Color fundus photograph.
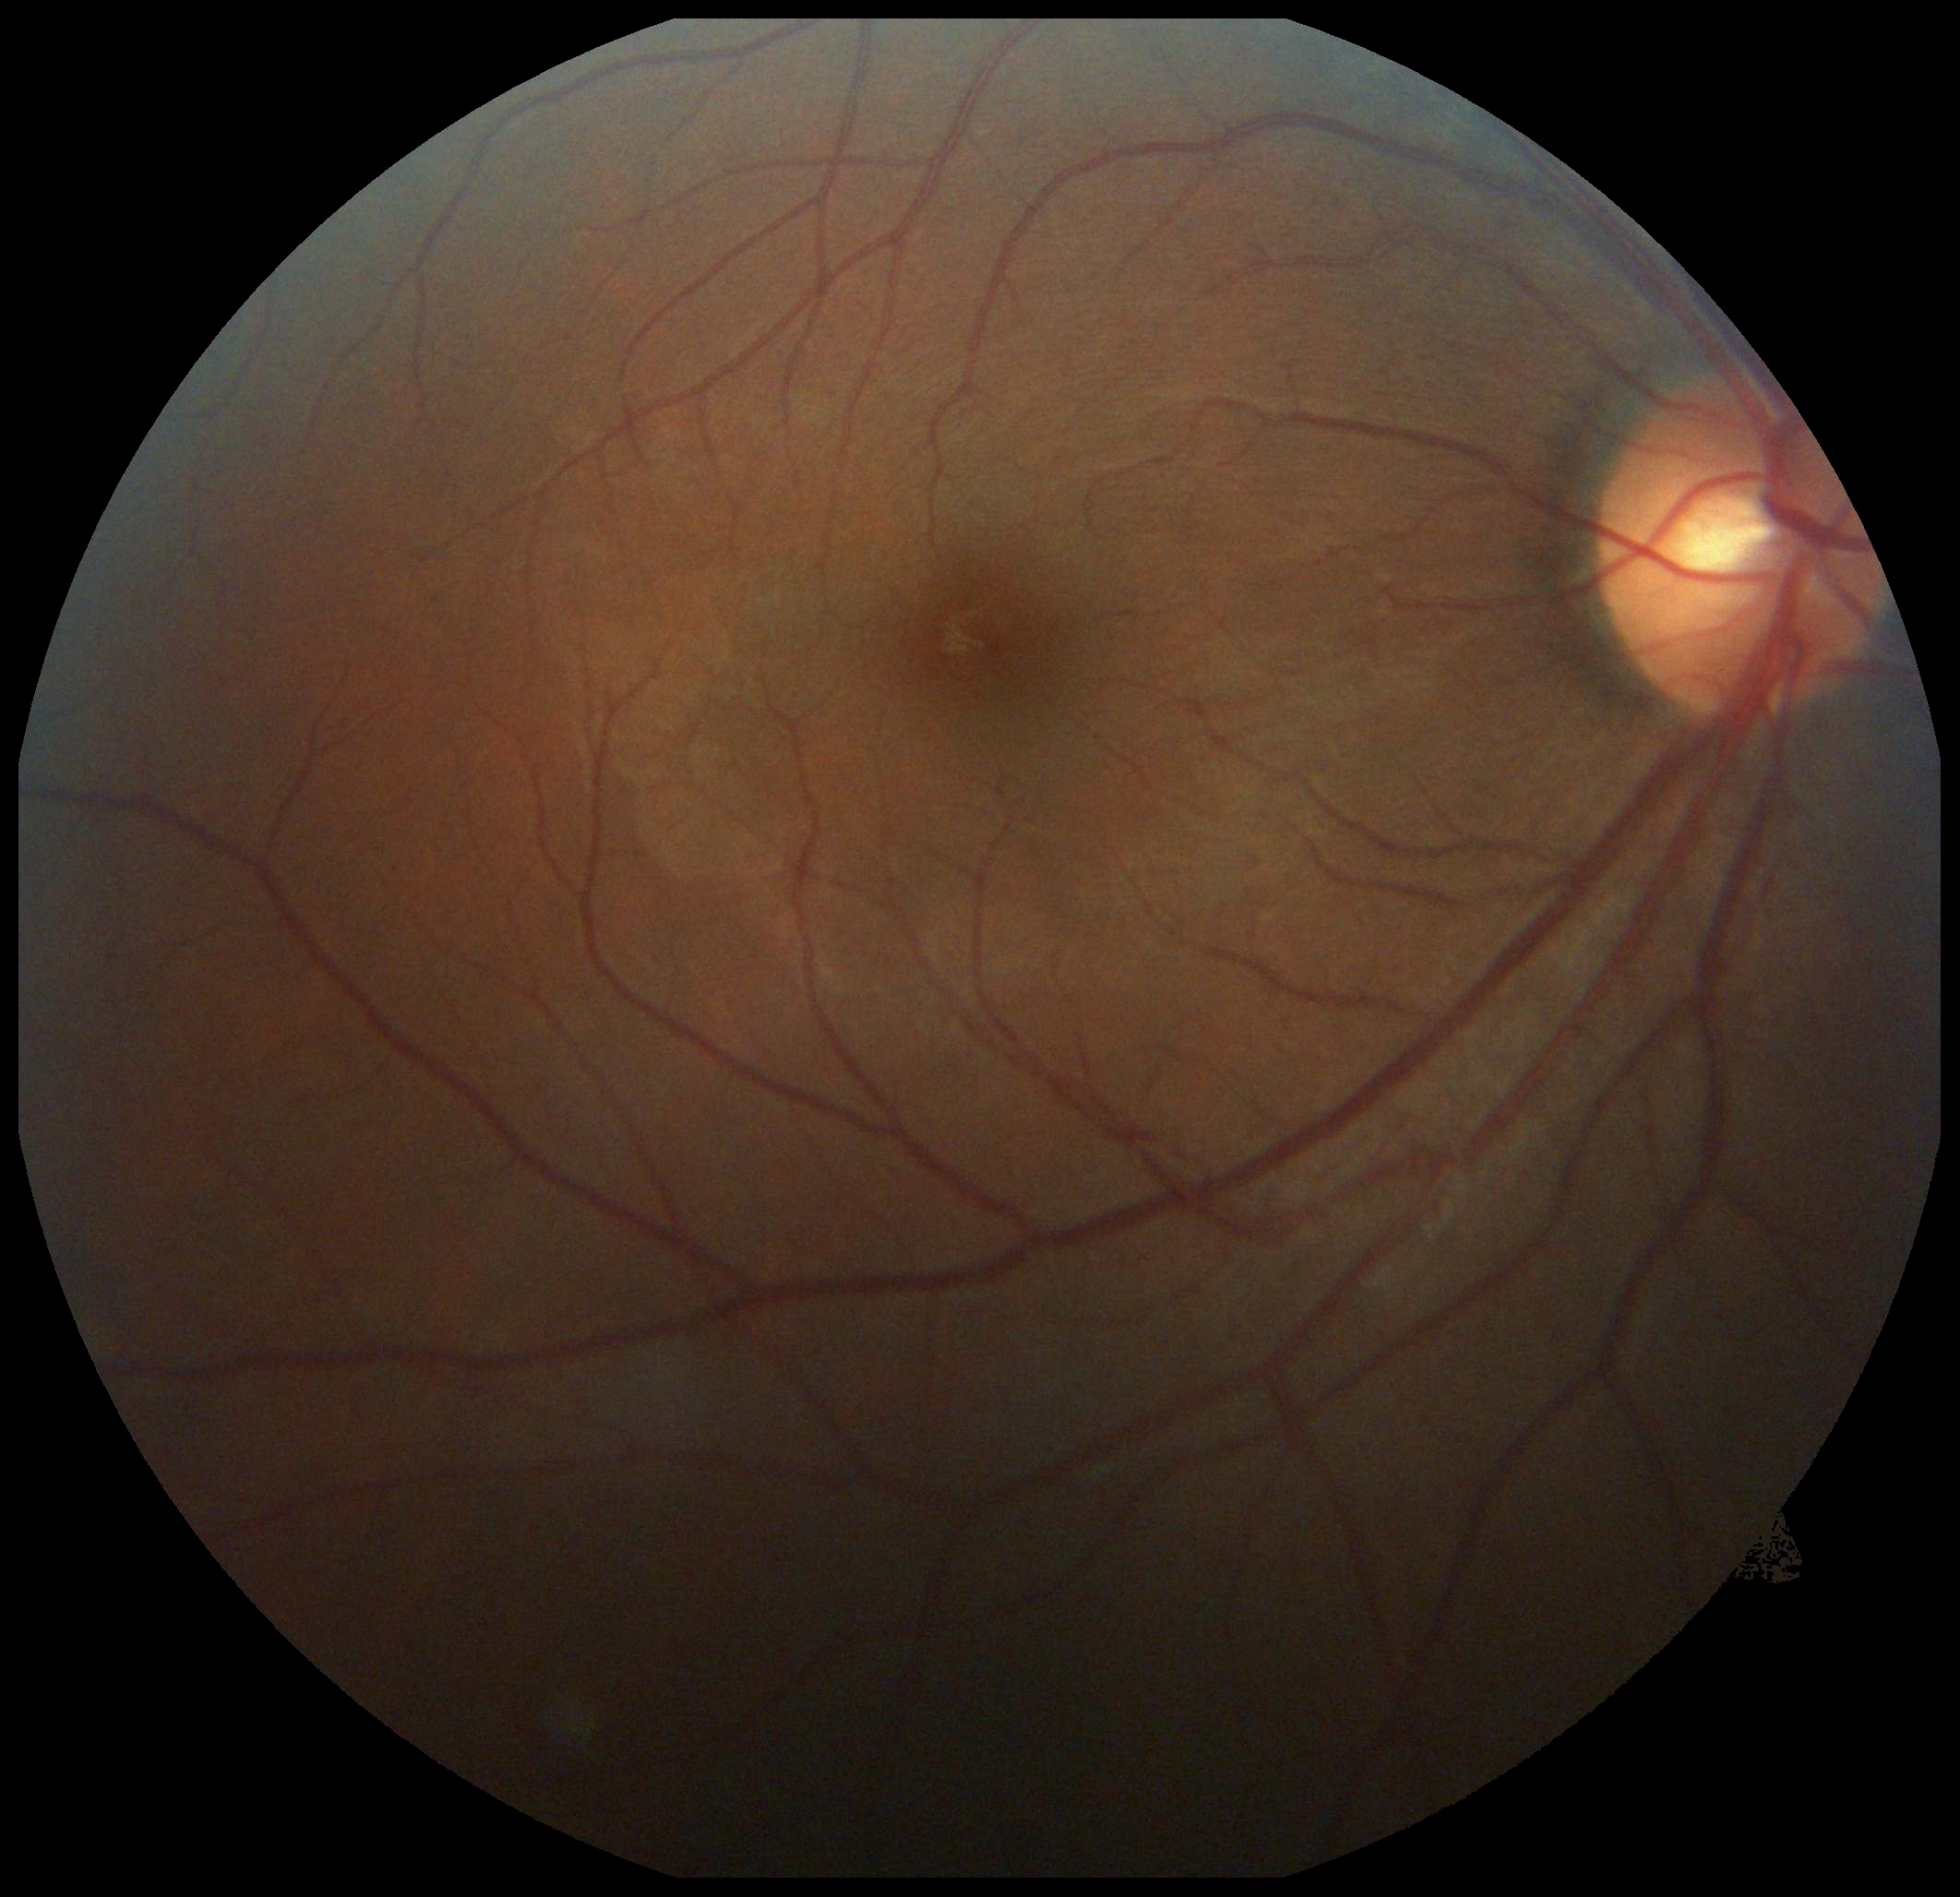

diabetic retinopathy (DR) = no apparent diabetic retinopathy (grade 0).